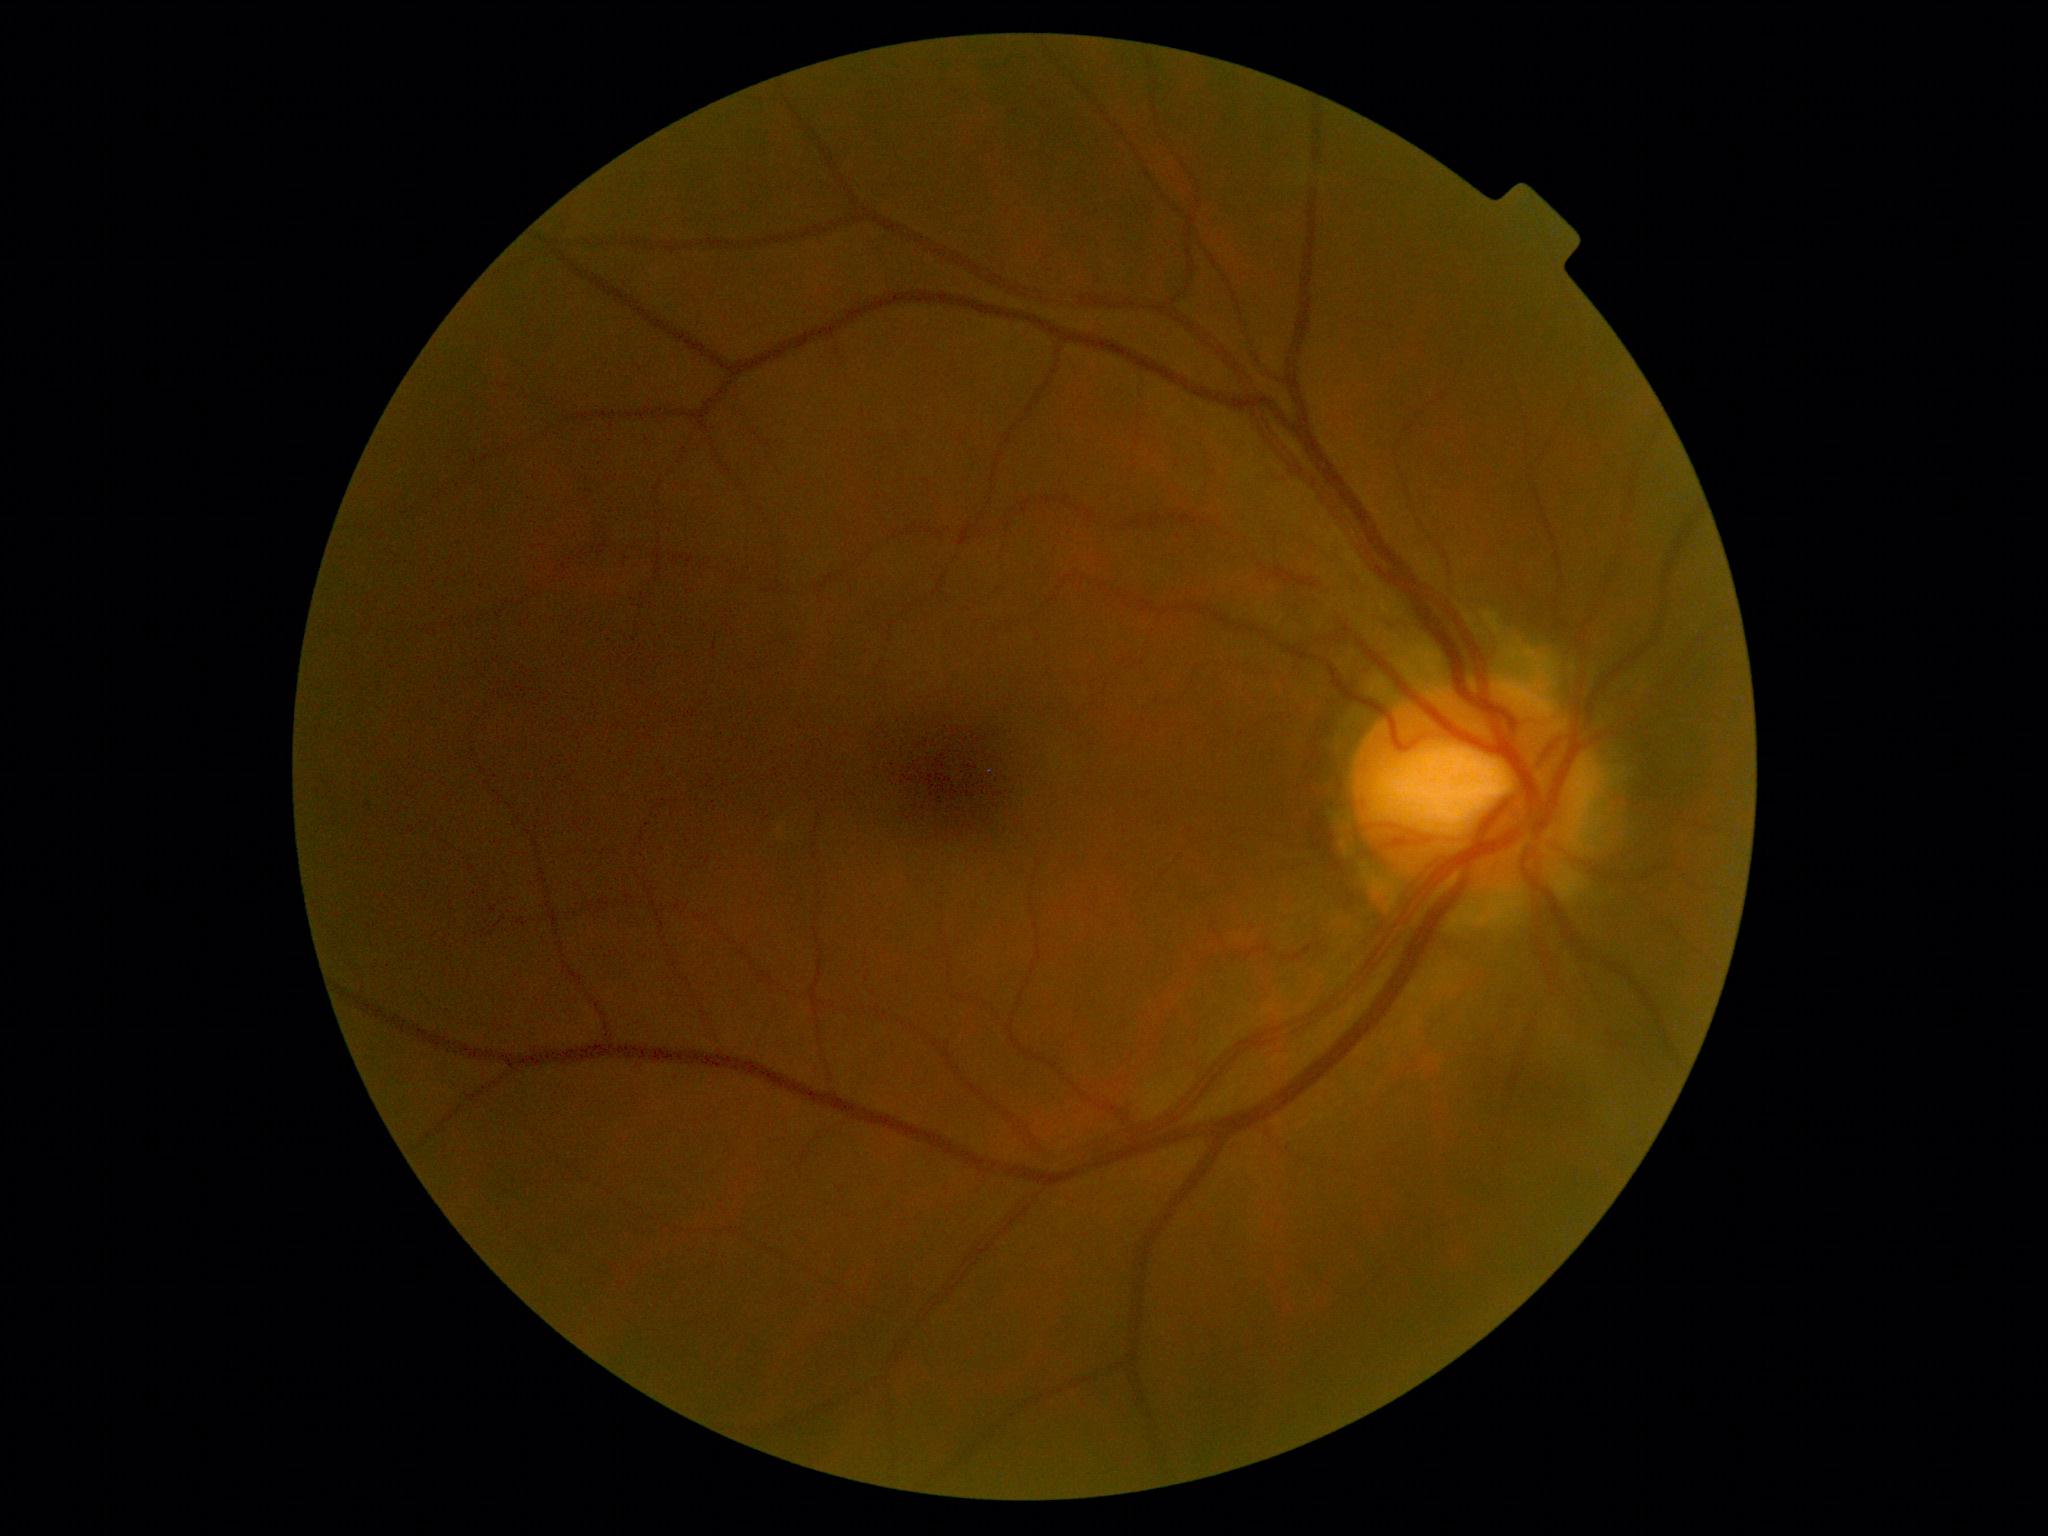 DR stage: no apparent diabetic retinopathy (grade 0).